Posterior pole color fundus photograph, camera: NIDEK AFC-230 — 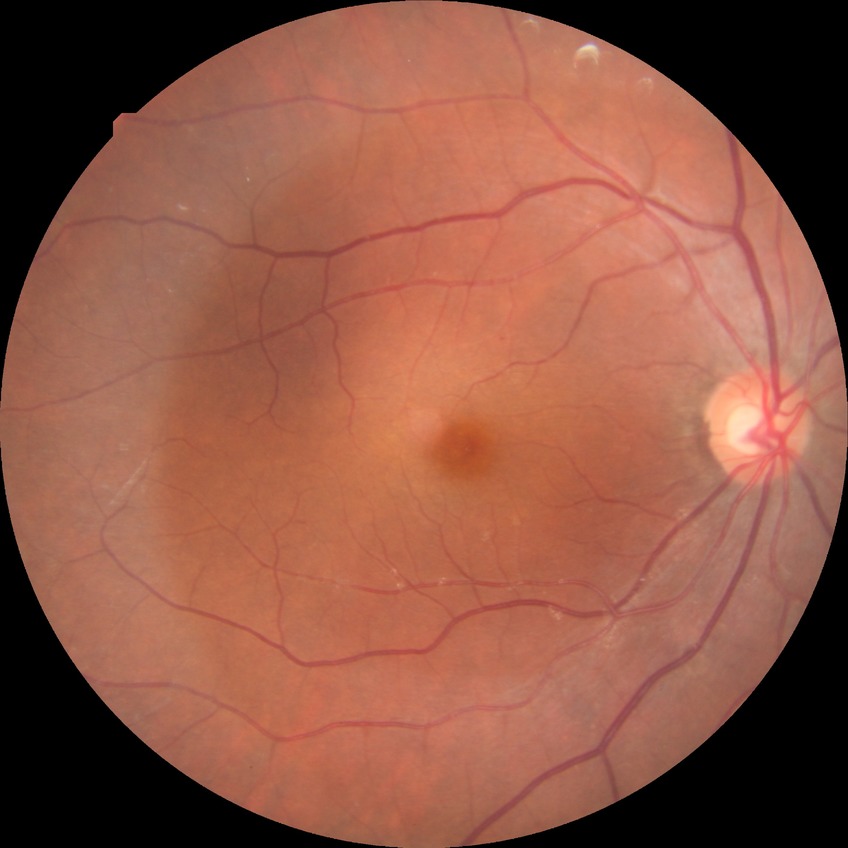 Davis grading: simple diabetic retinopathy | DR class: non-proliferative diabetic retinopathy.